CFP · image size 2212x1659 · 45° field of view — 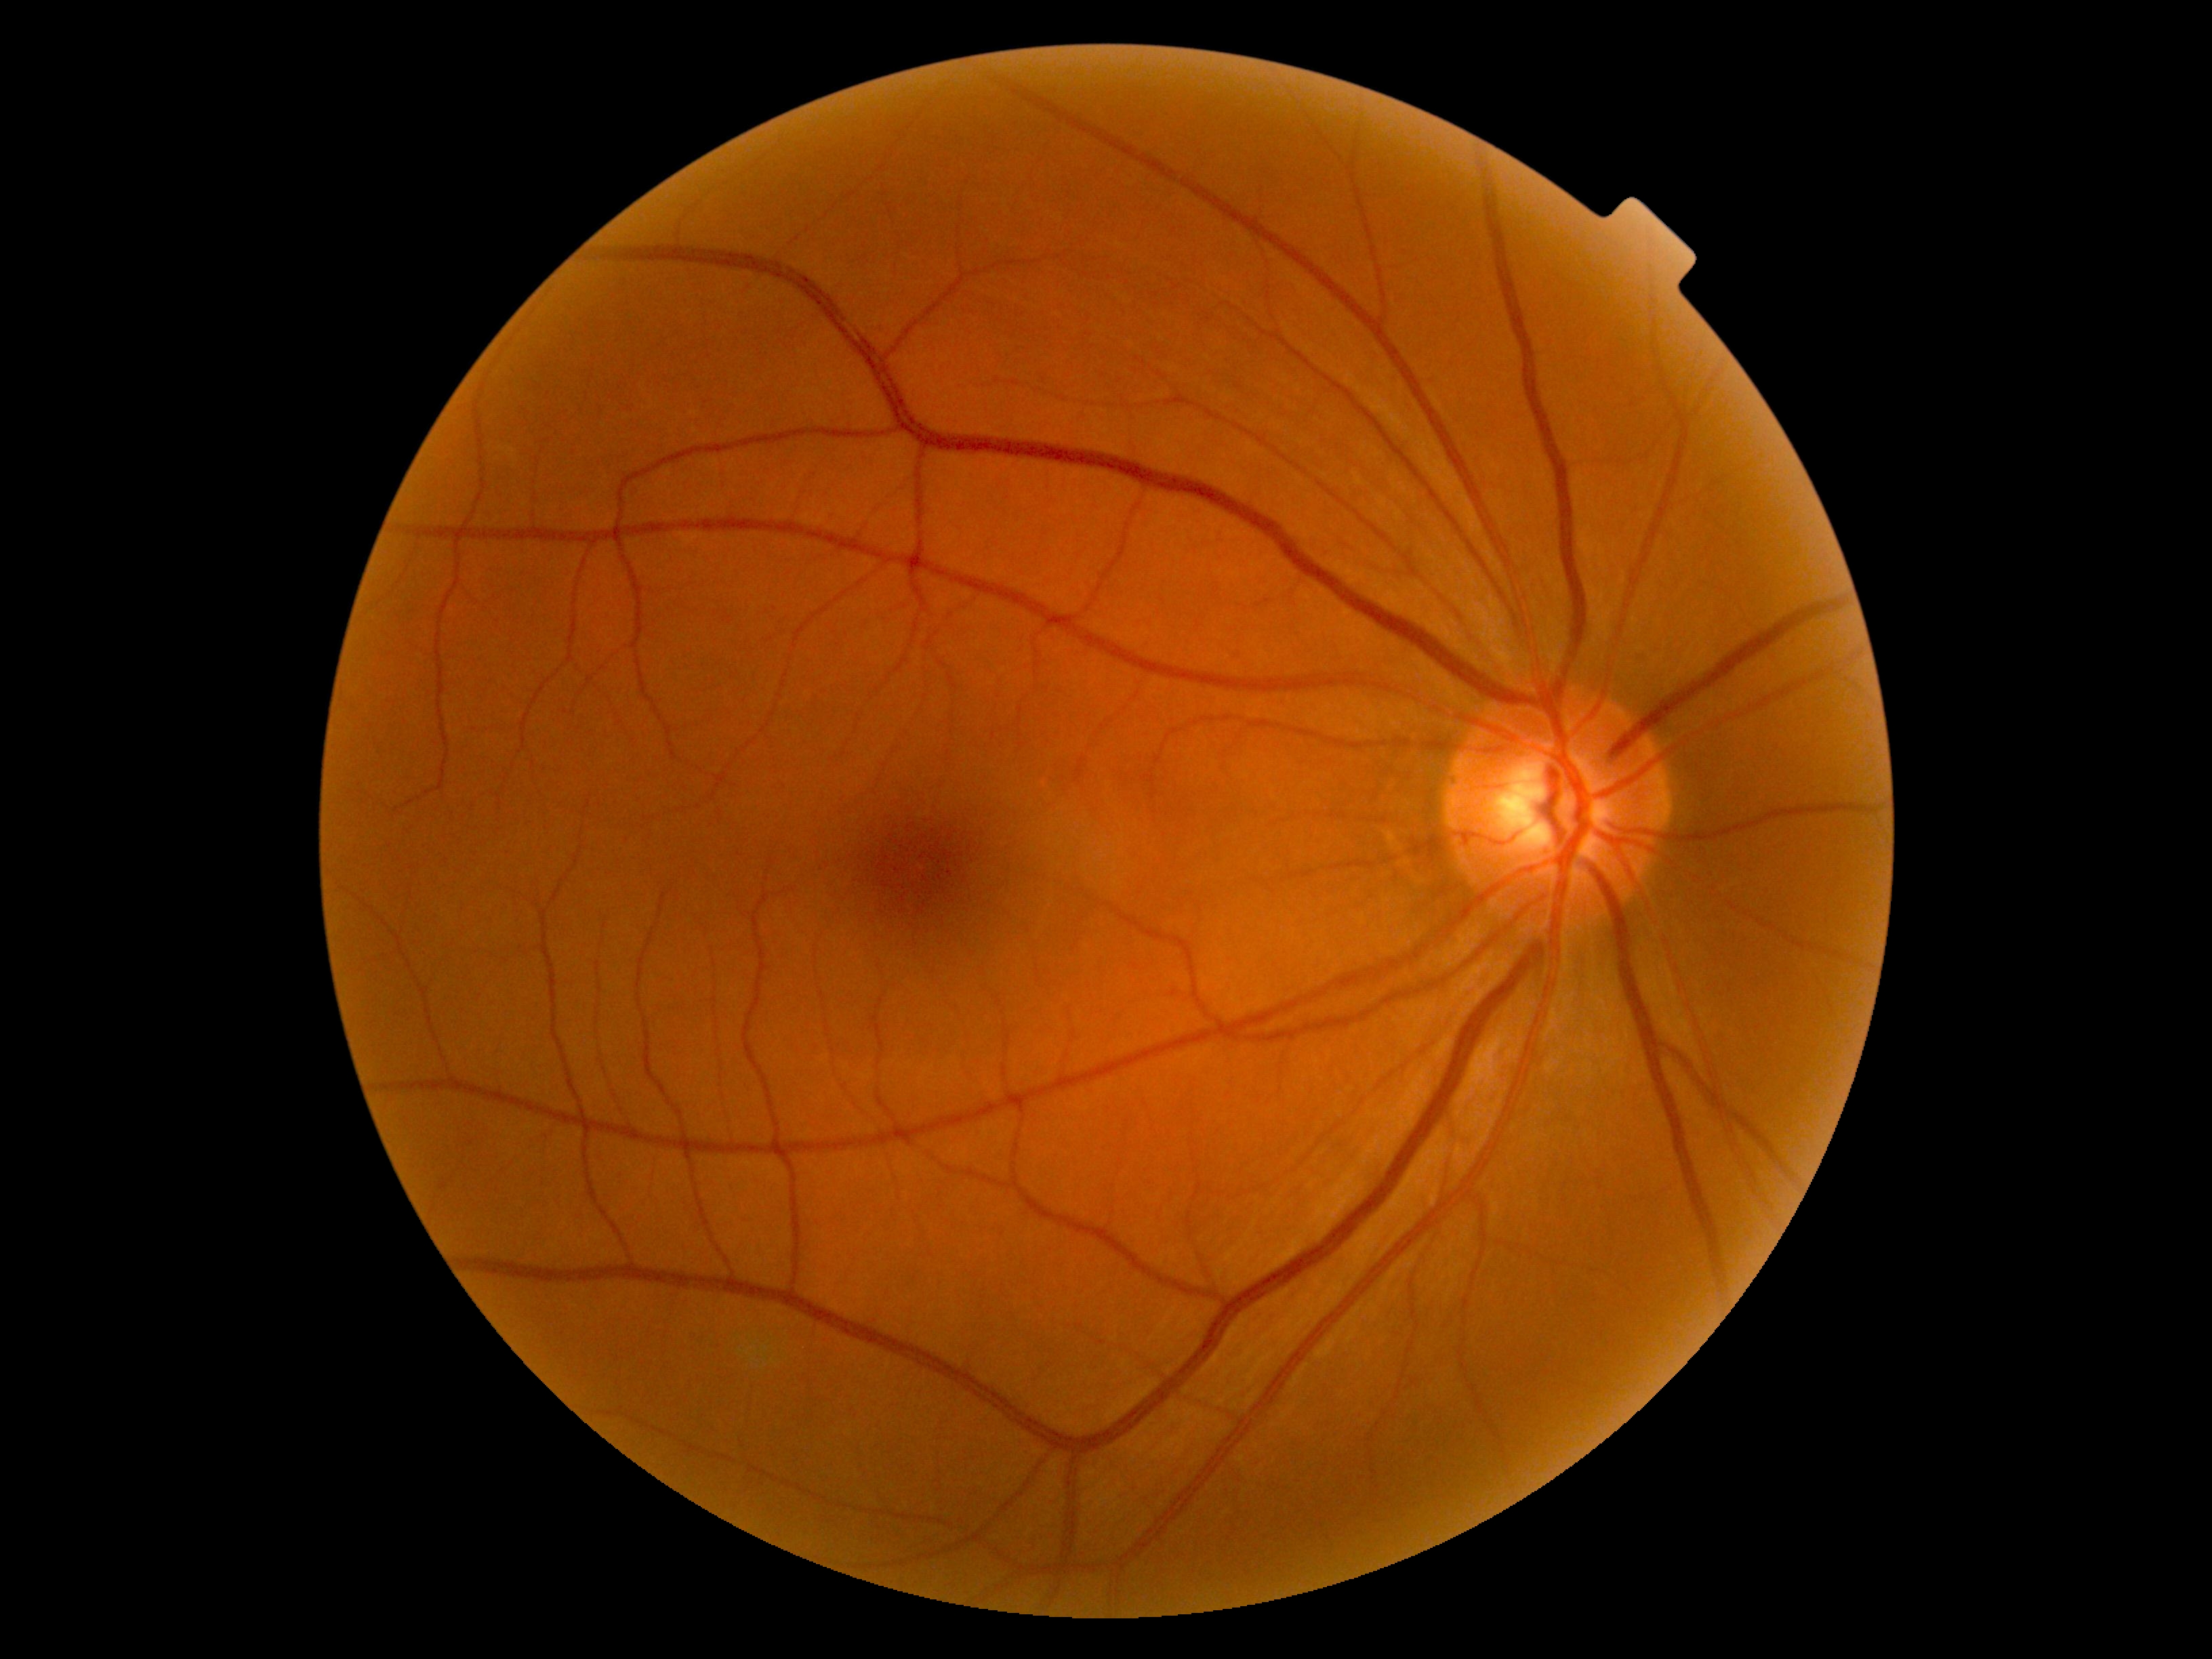
Diabetic retinopathy (DR) is no apparent retinopathy (grade 0).
No DR findings.